Posterior pole photograph — 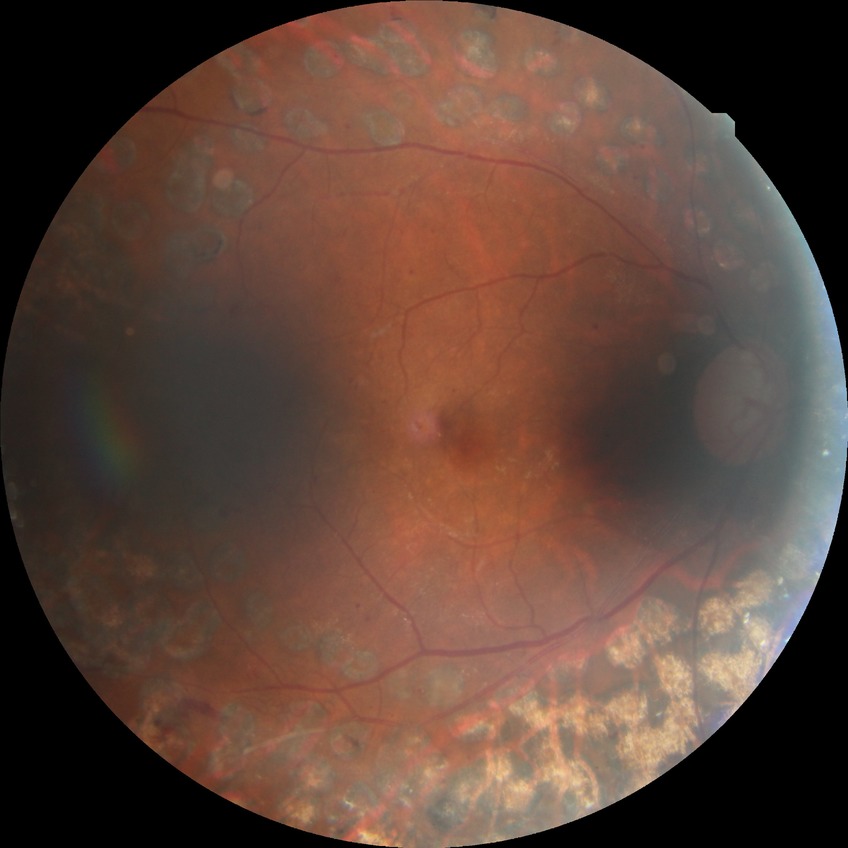 DR stage = PDR.